45° field of view — 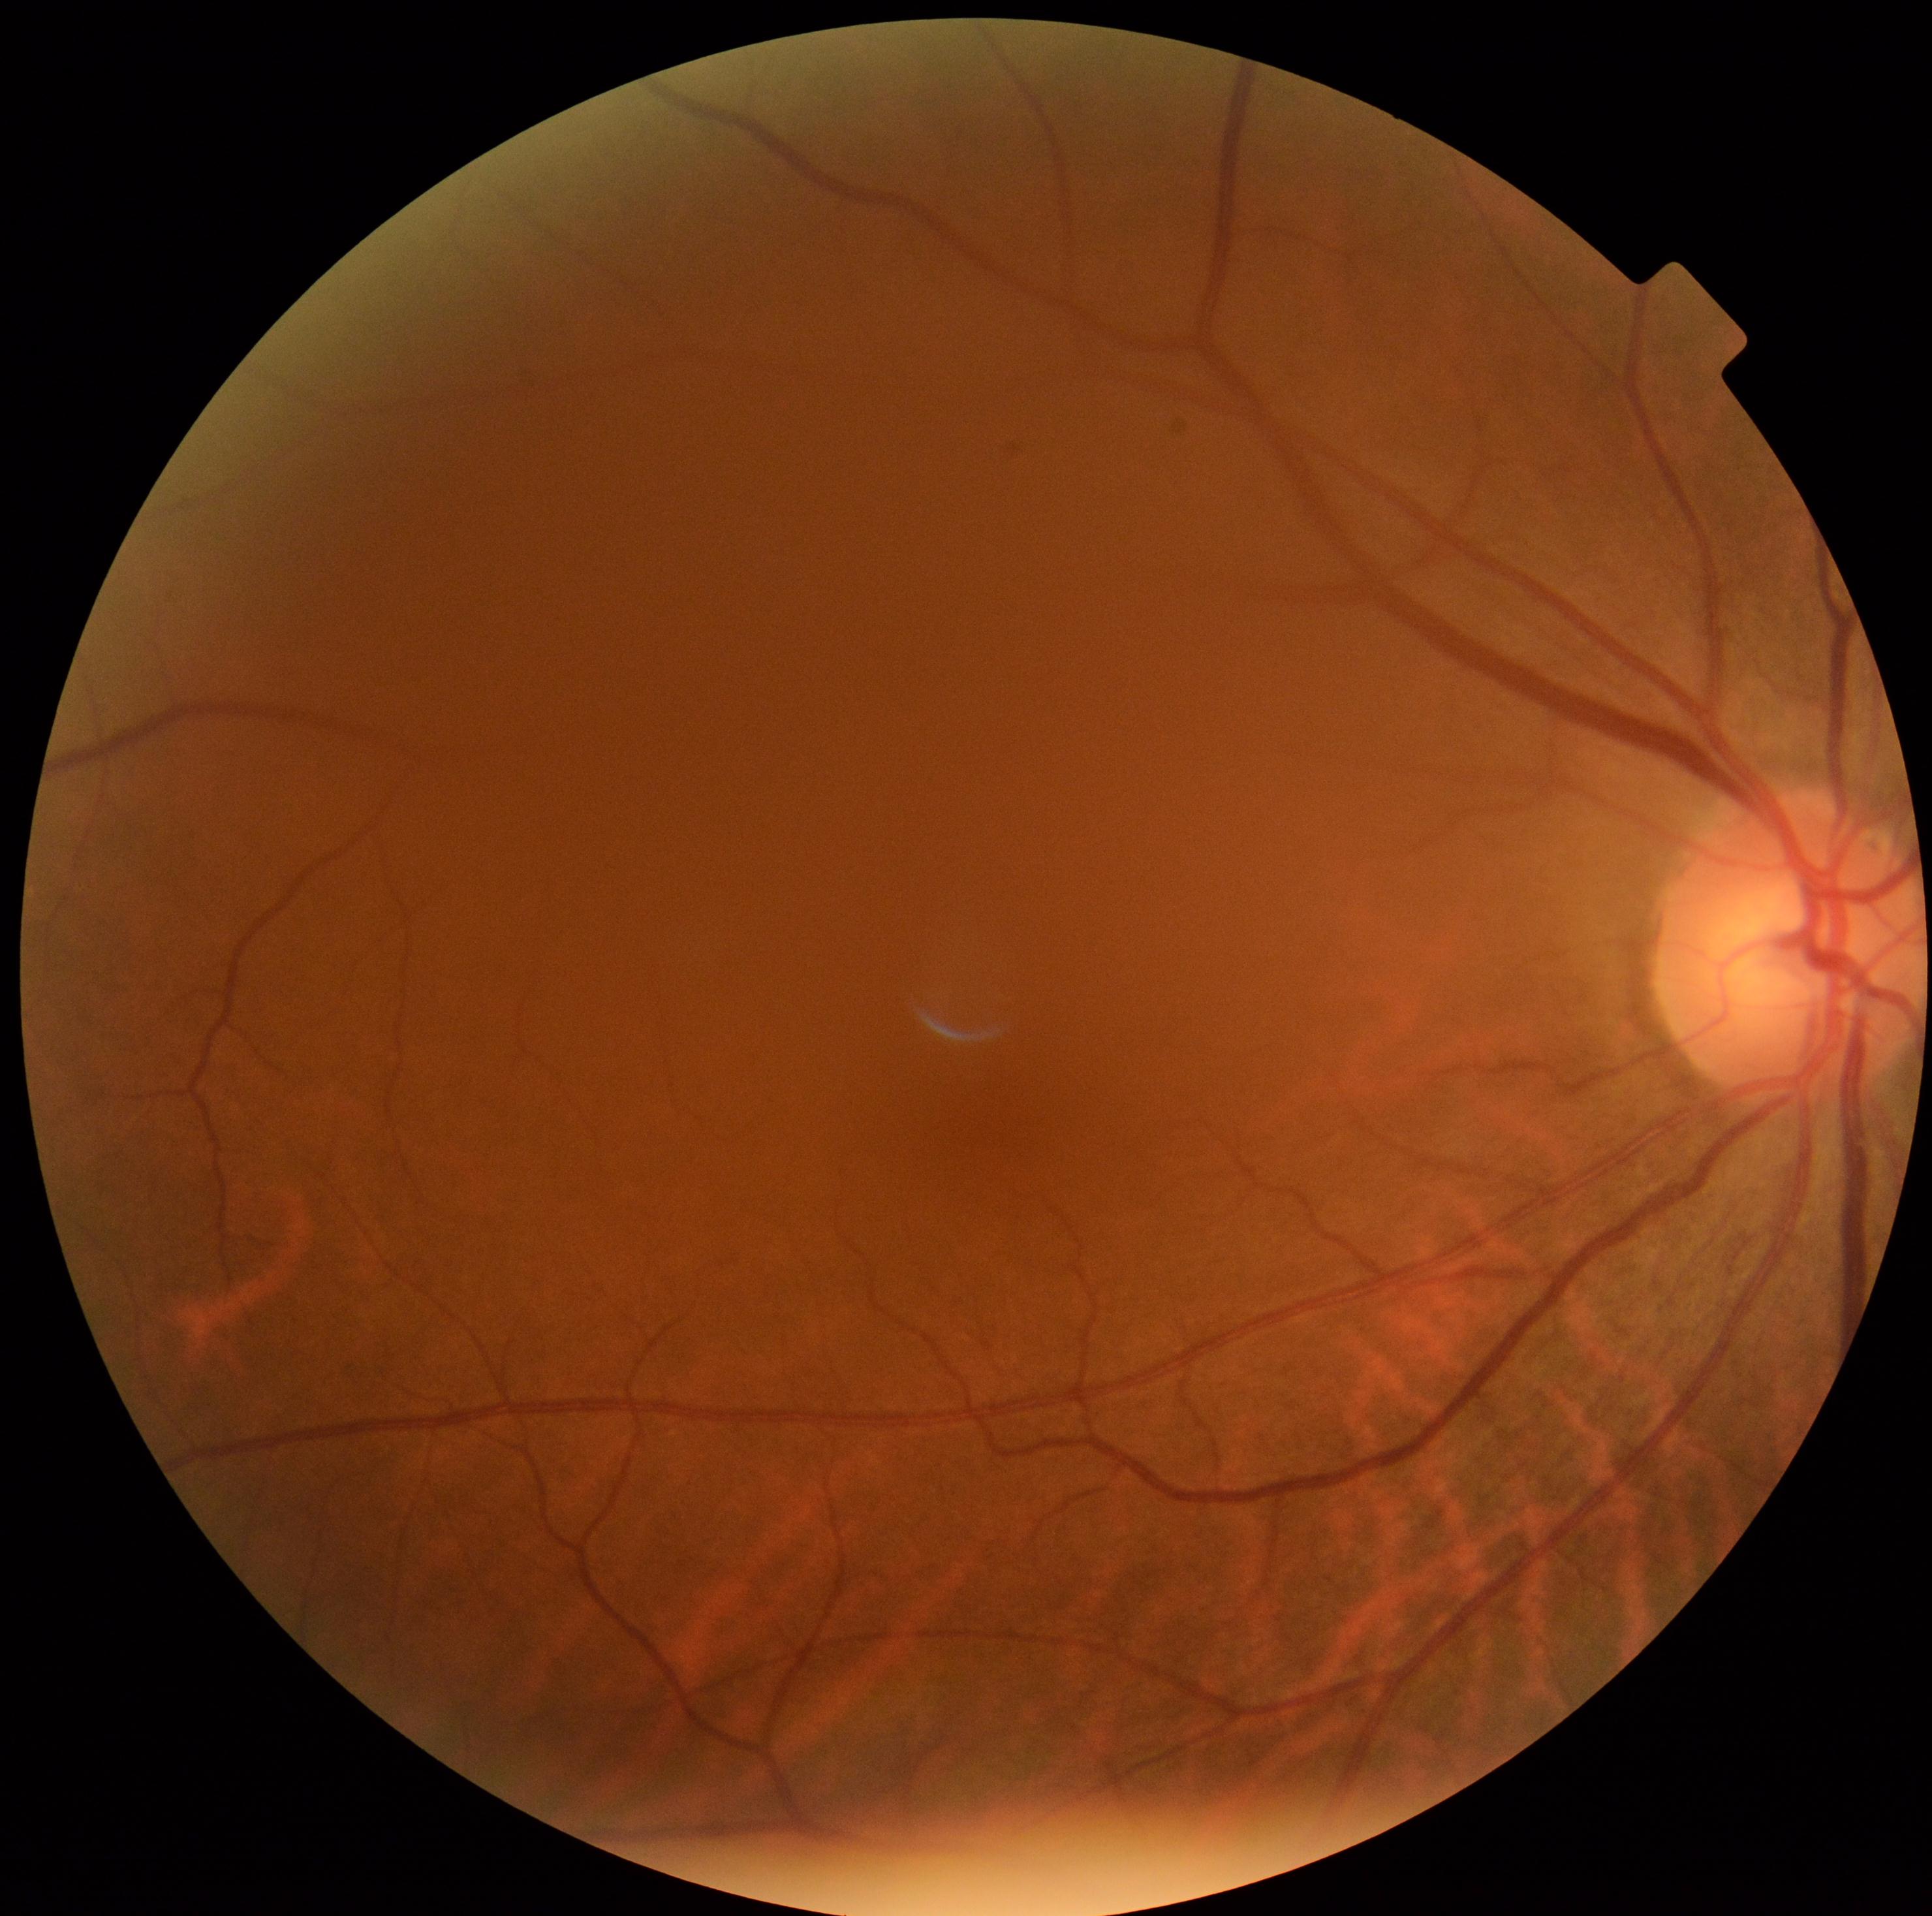
DR severity@0/4, DR impression@no DR findings.